CFP, nonmydriatic.
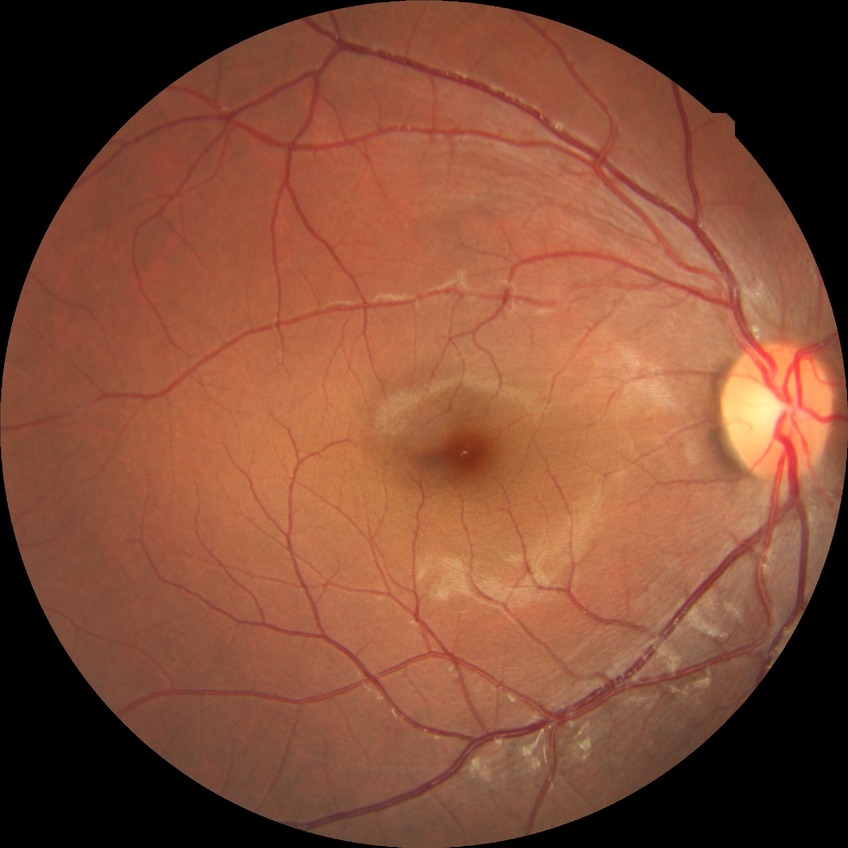
Davis grading: no diabetic retinopathy.